RetCam wide-field infant fundus image · acquired on the Clarity RetCam 3:
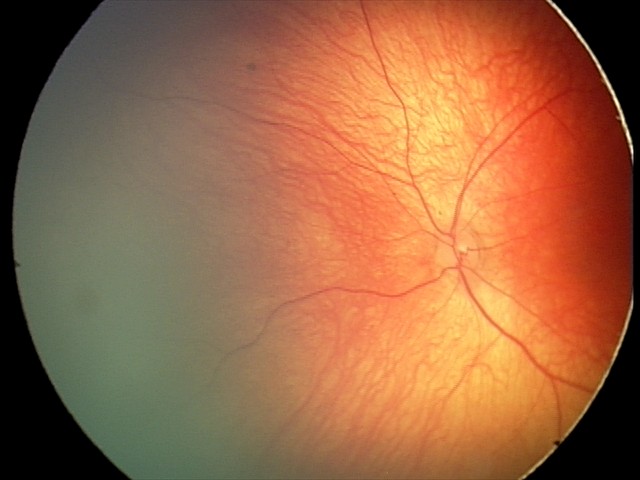

Screening examination diagnosed as physiological.